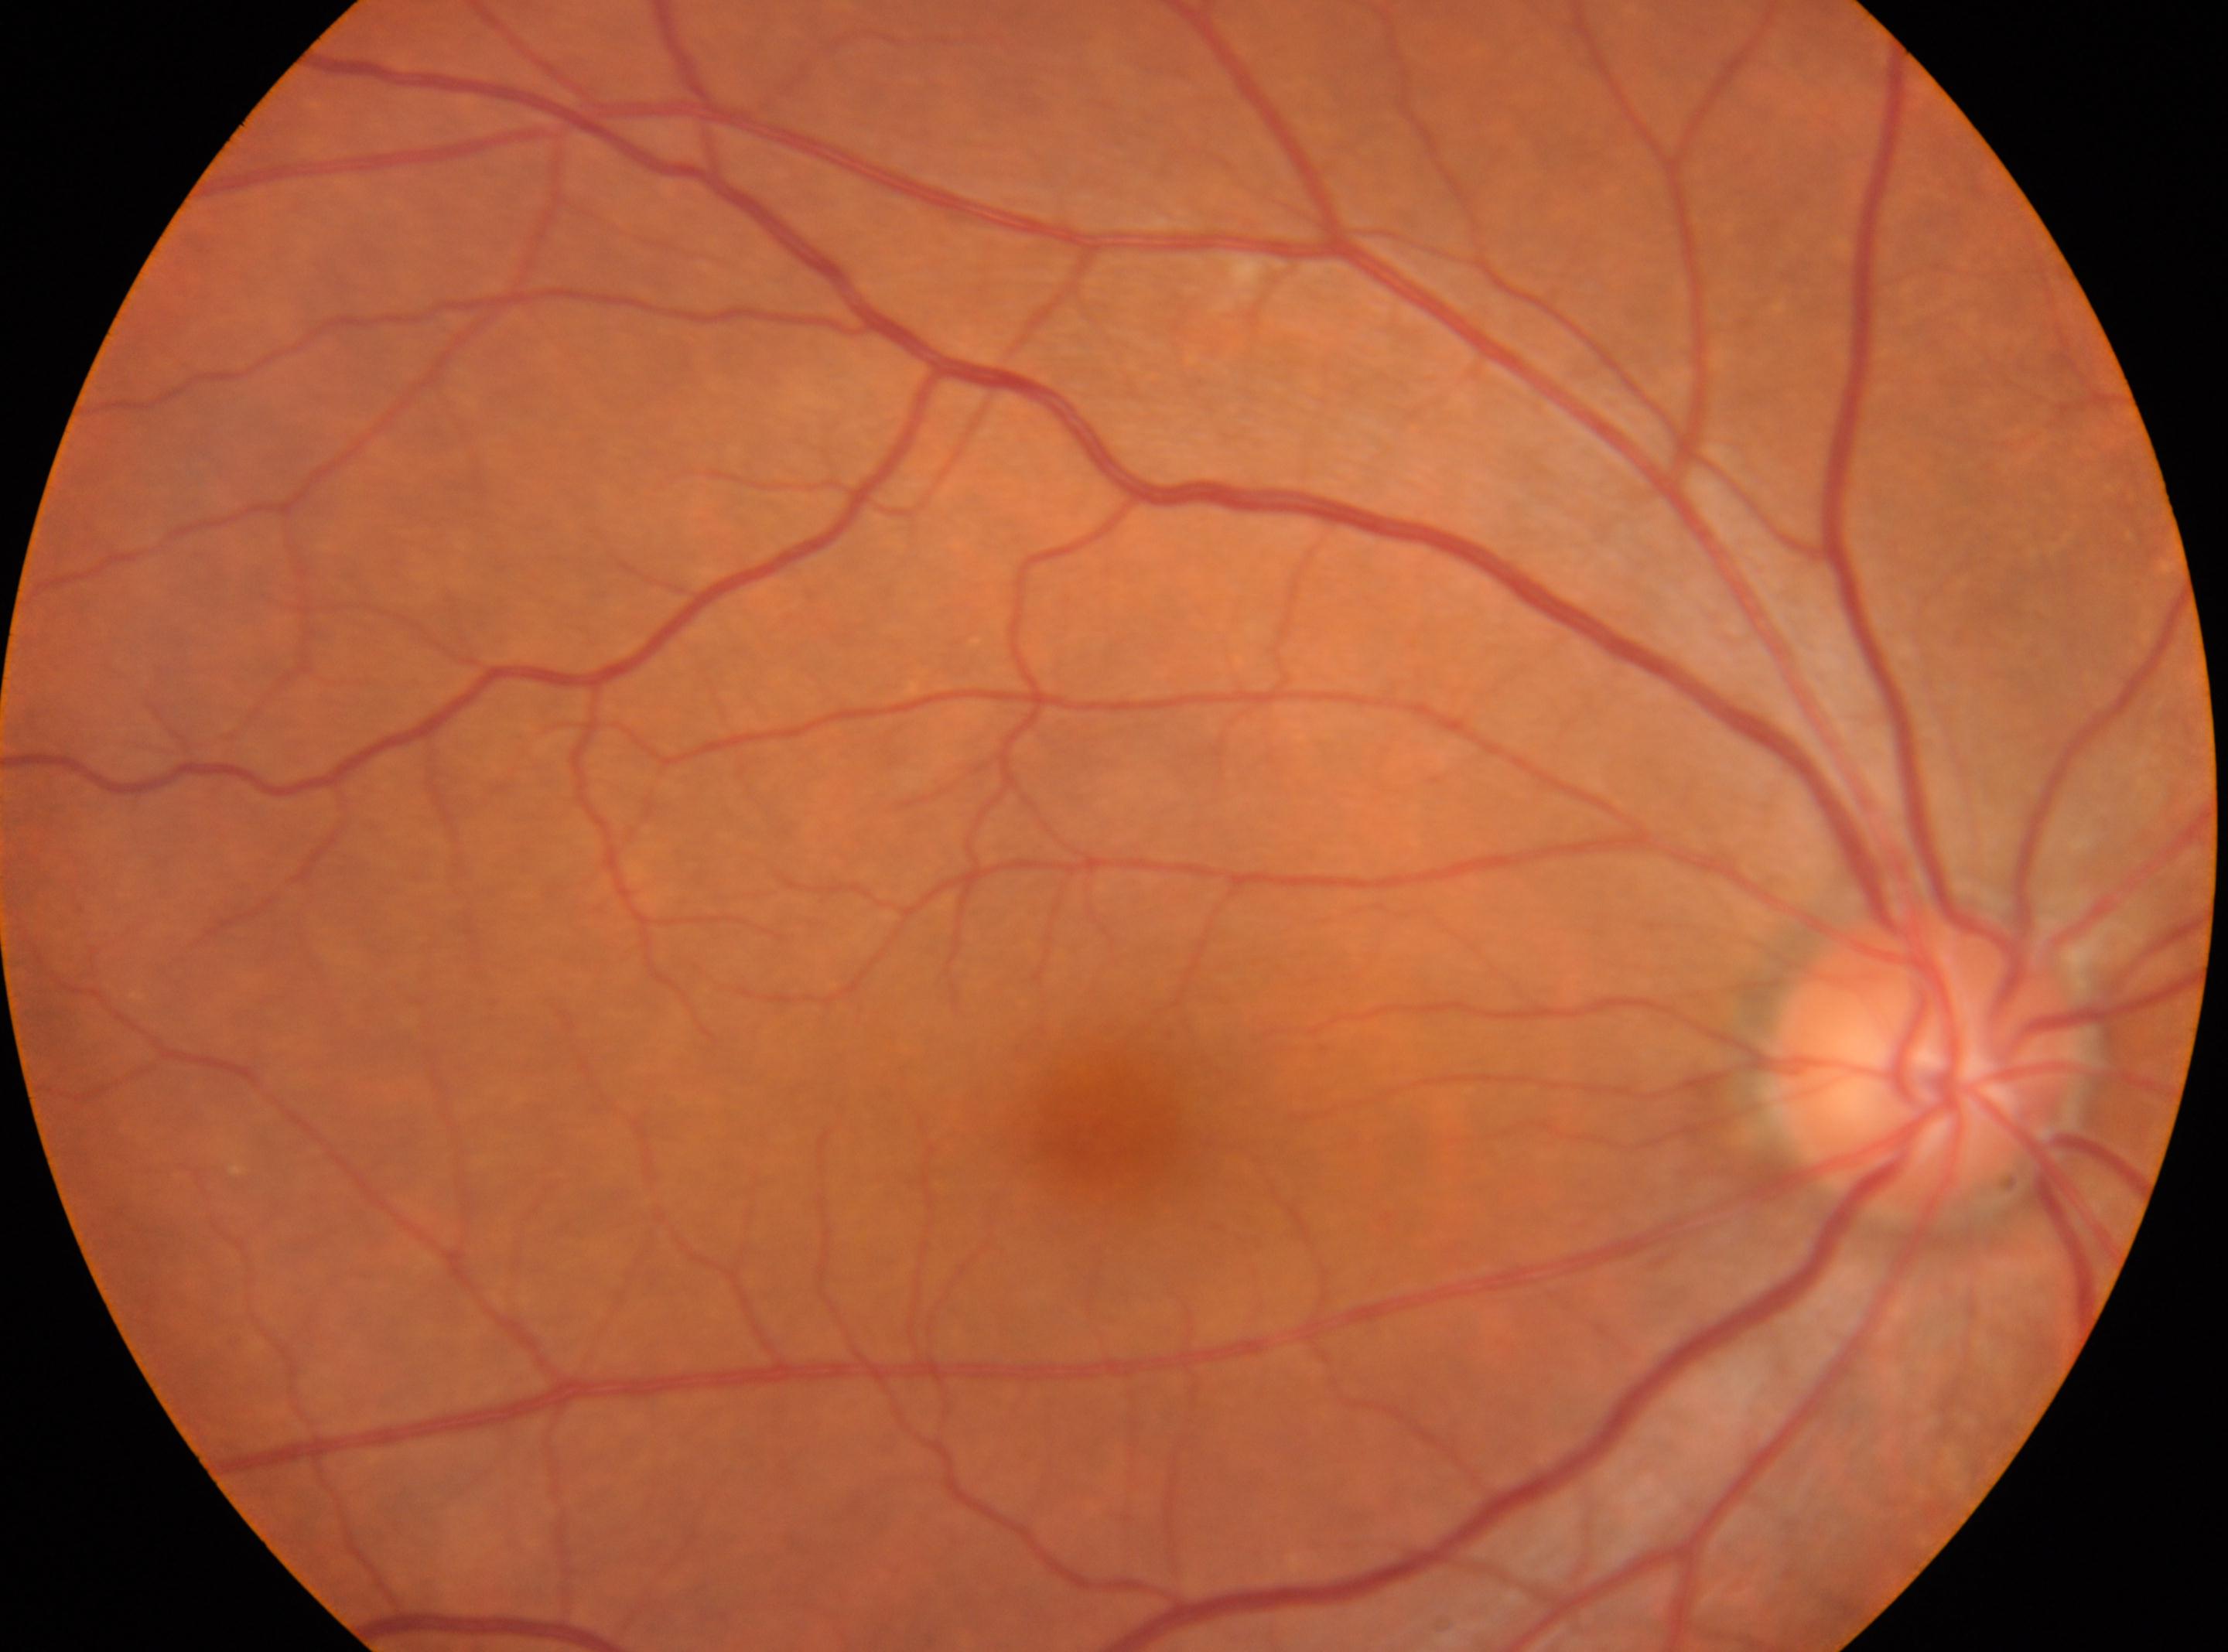

{"optic_disc": "(1925,1056)", "fovea": "(1105,1128)", "dr_grade": "0", "eye": "the right eye"}